CFP
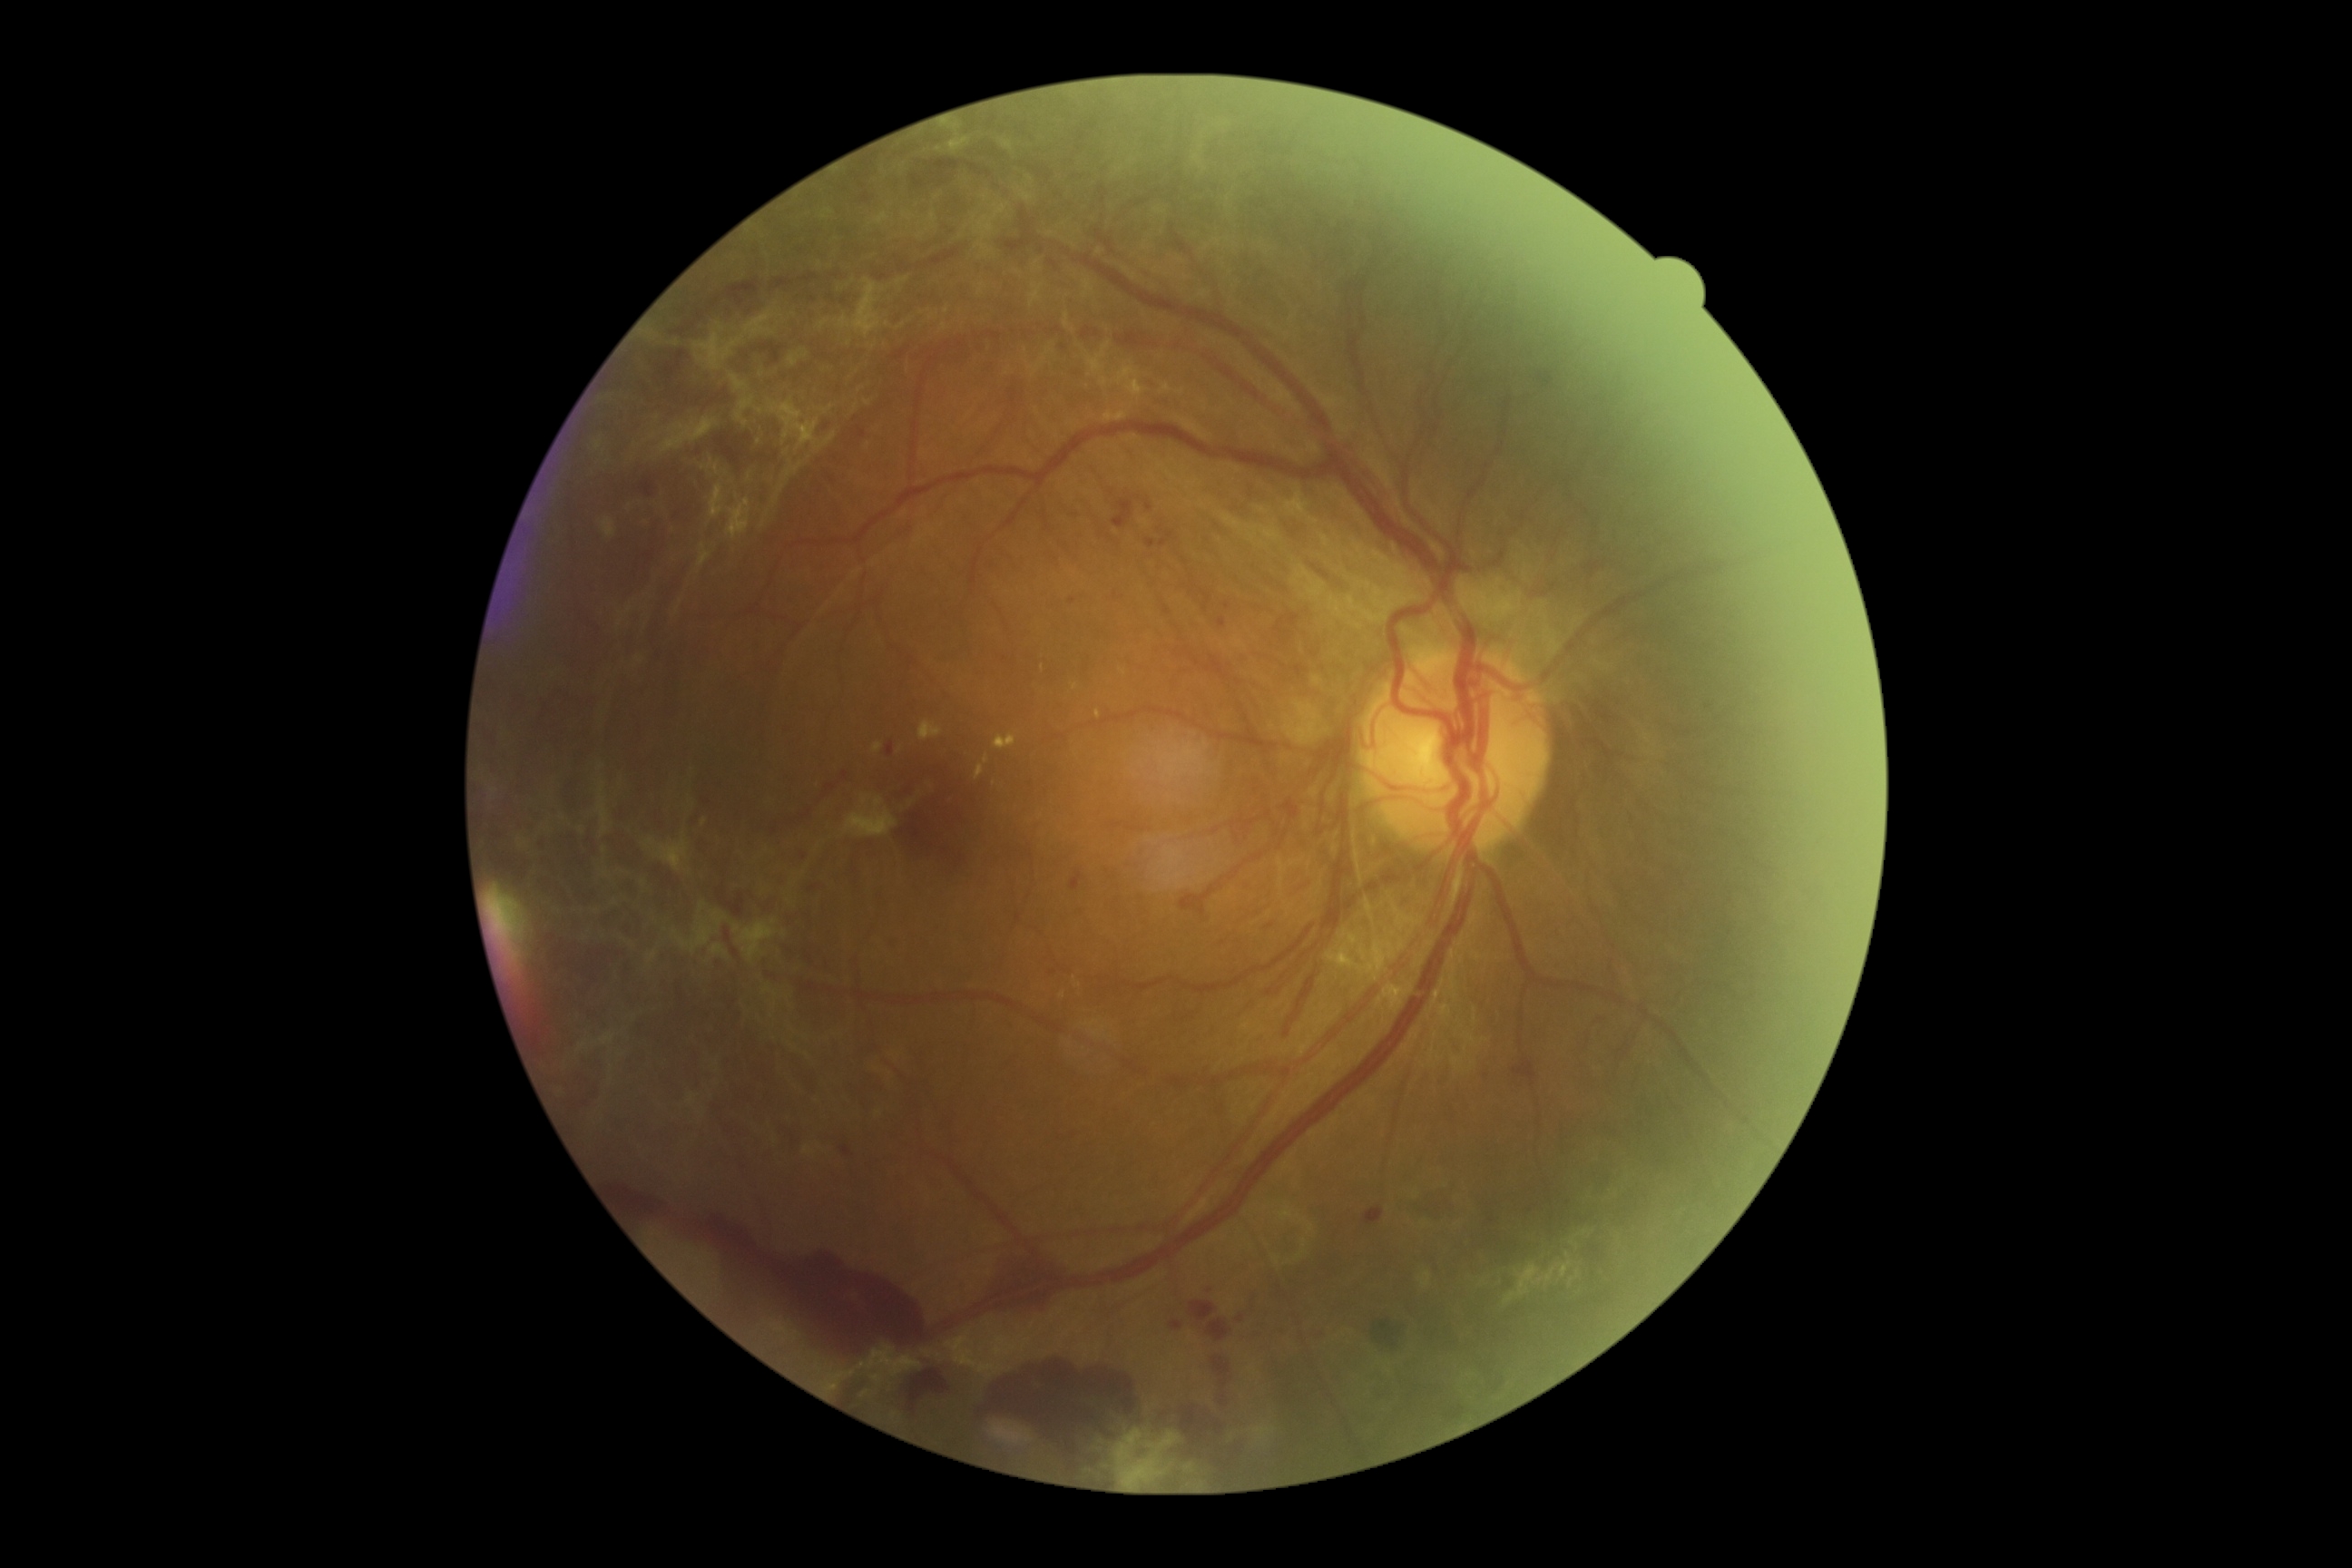 {"dr_grade": "grade 4 — neovascularization and/or vitreous/pre-retinal hemorrhage"}